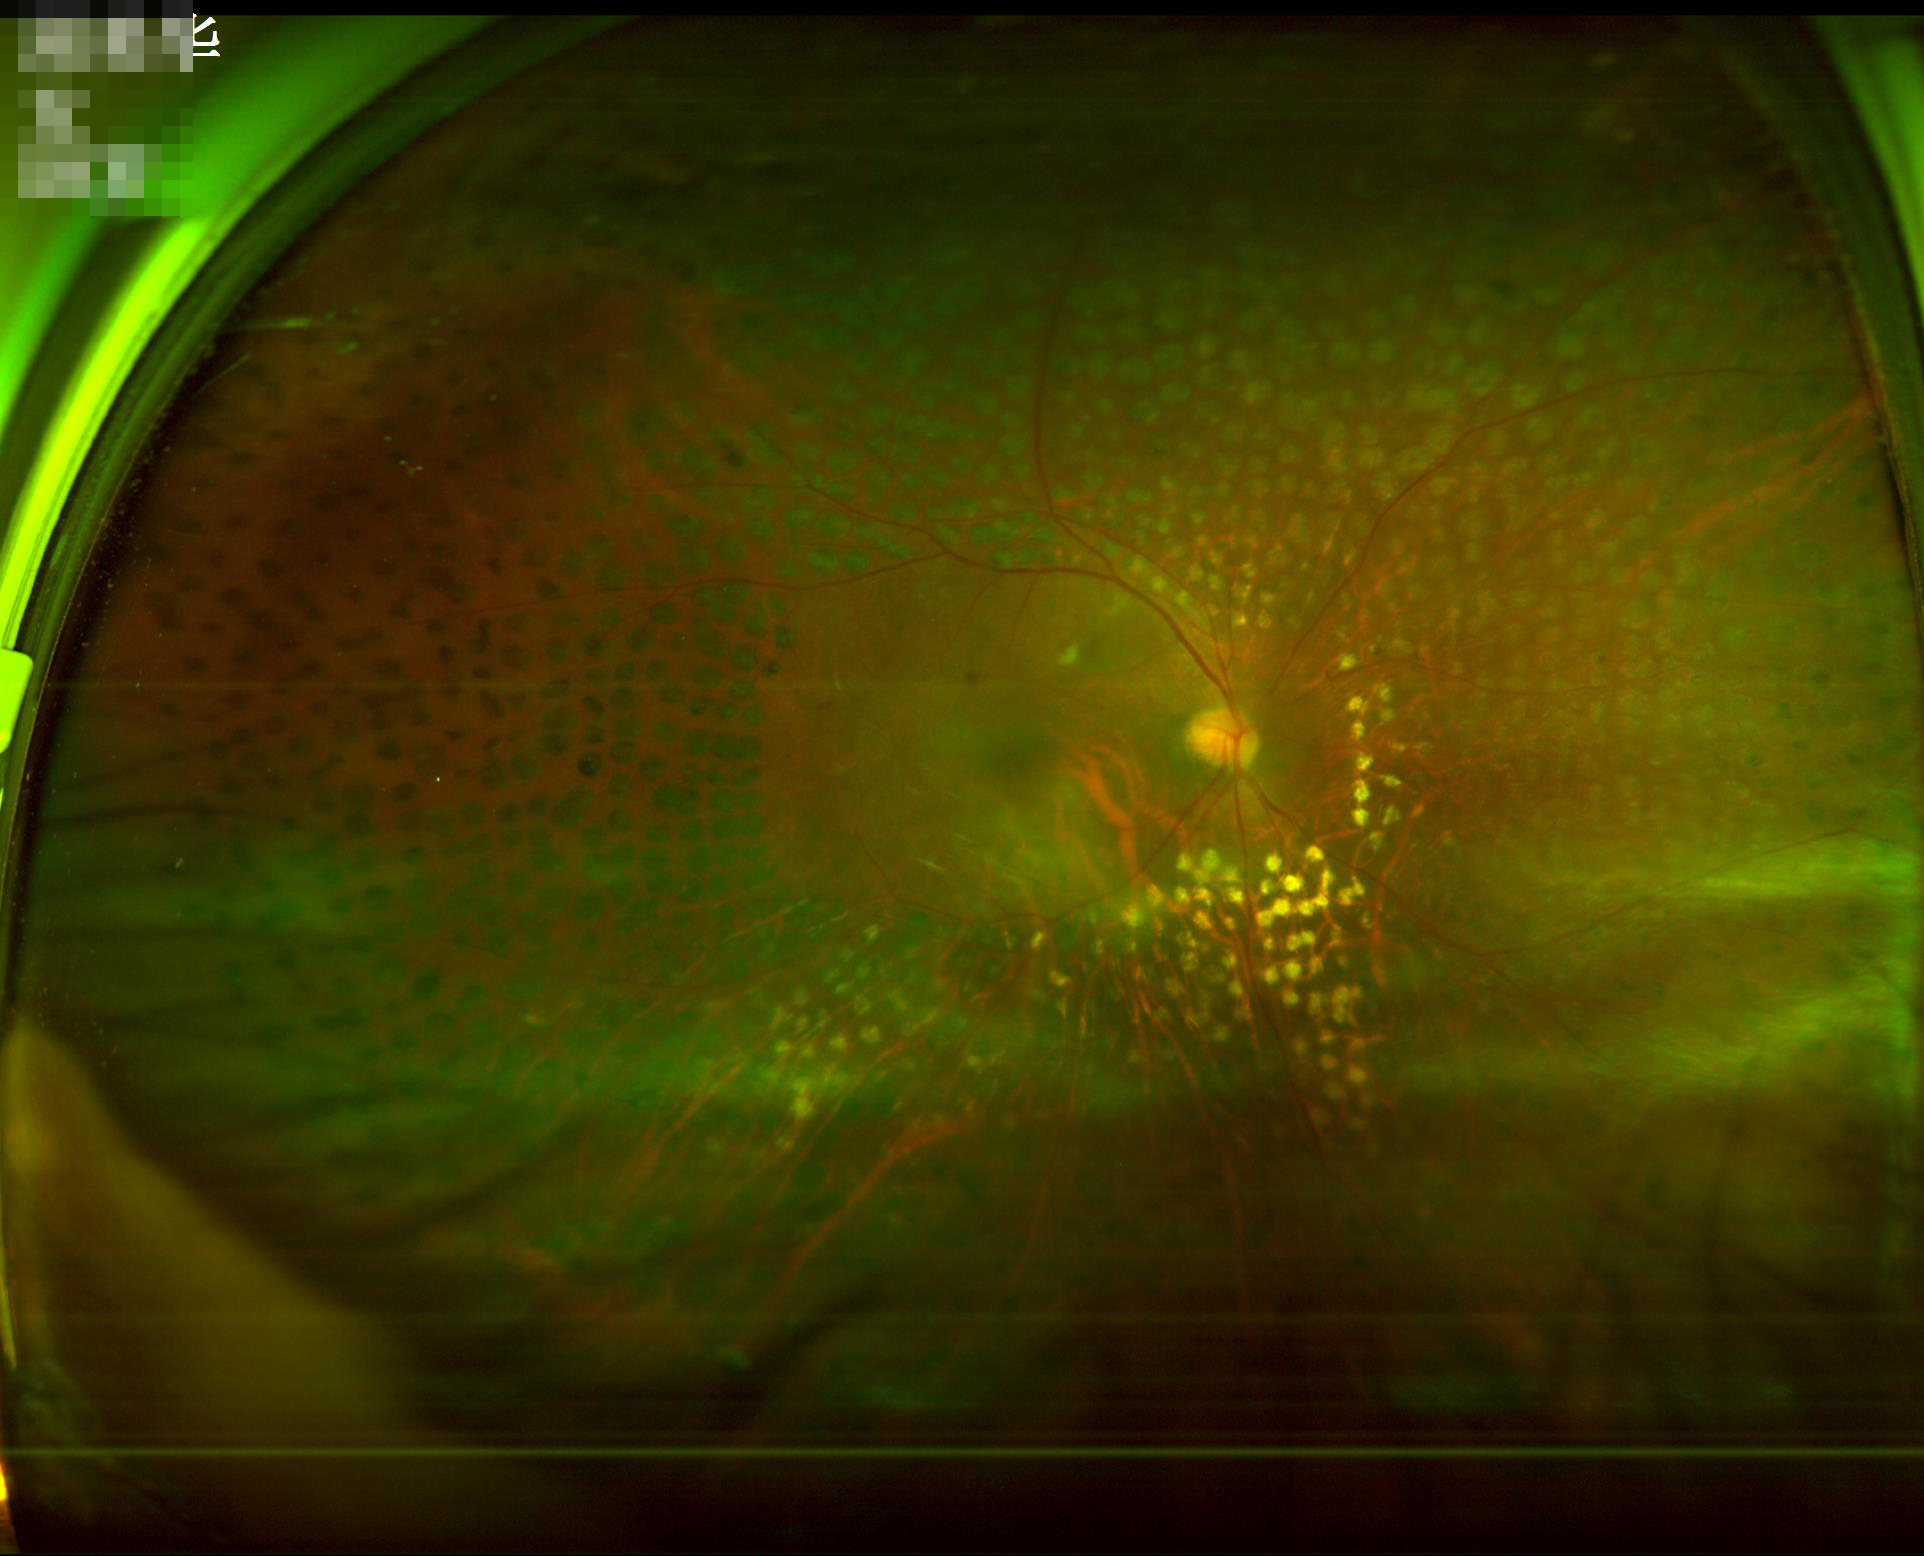
Overall quality is good and the image is gradable.
The image is blurry.